45° FOV — 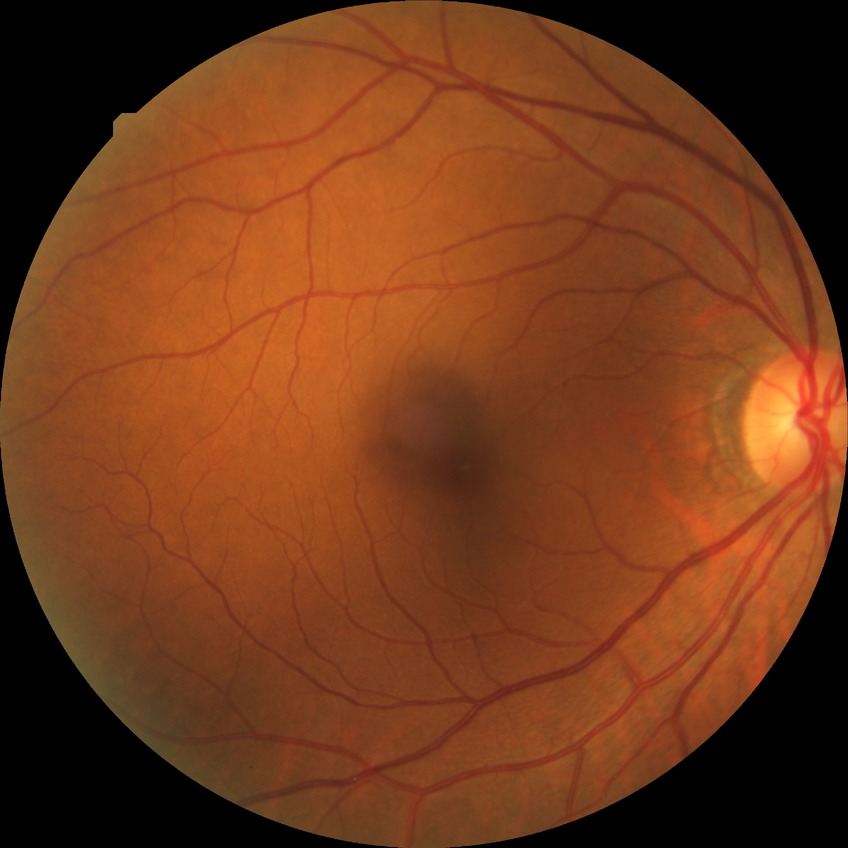
Diabetic retinopathy severity is no diabetic retinopathy.